45° field of view: 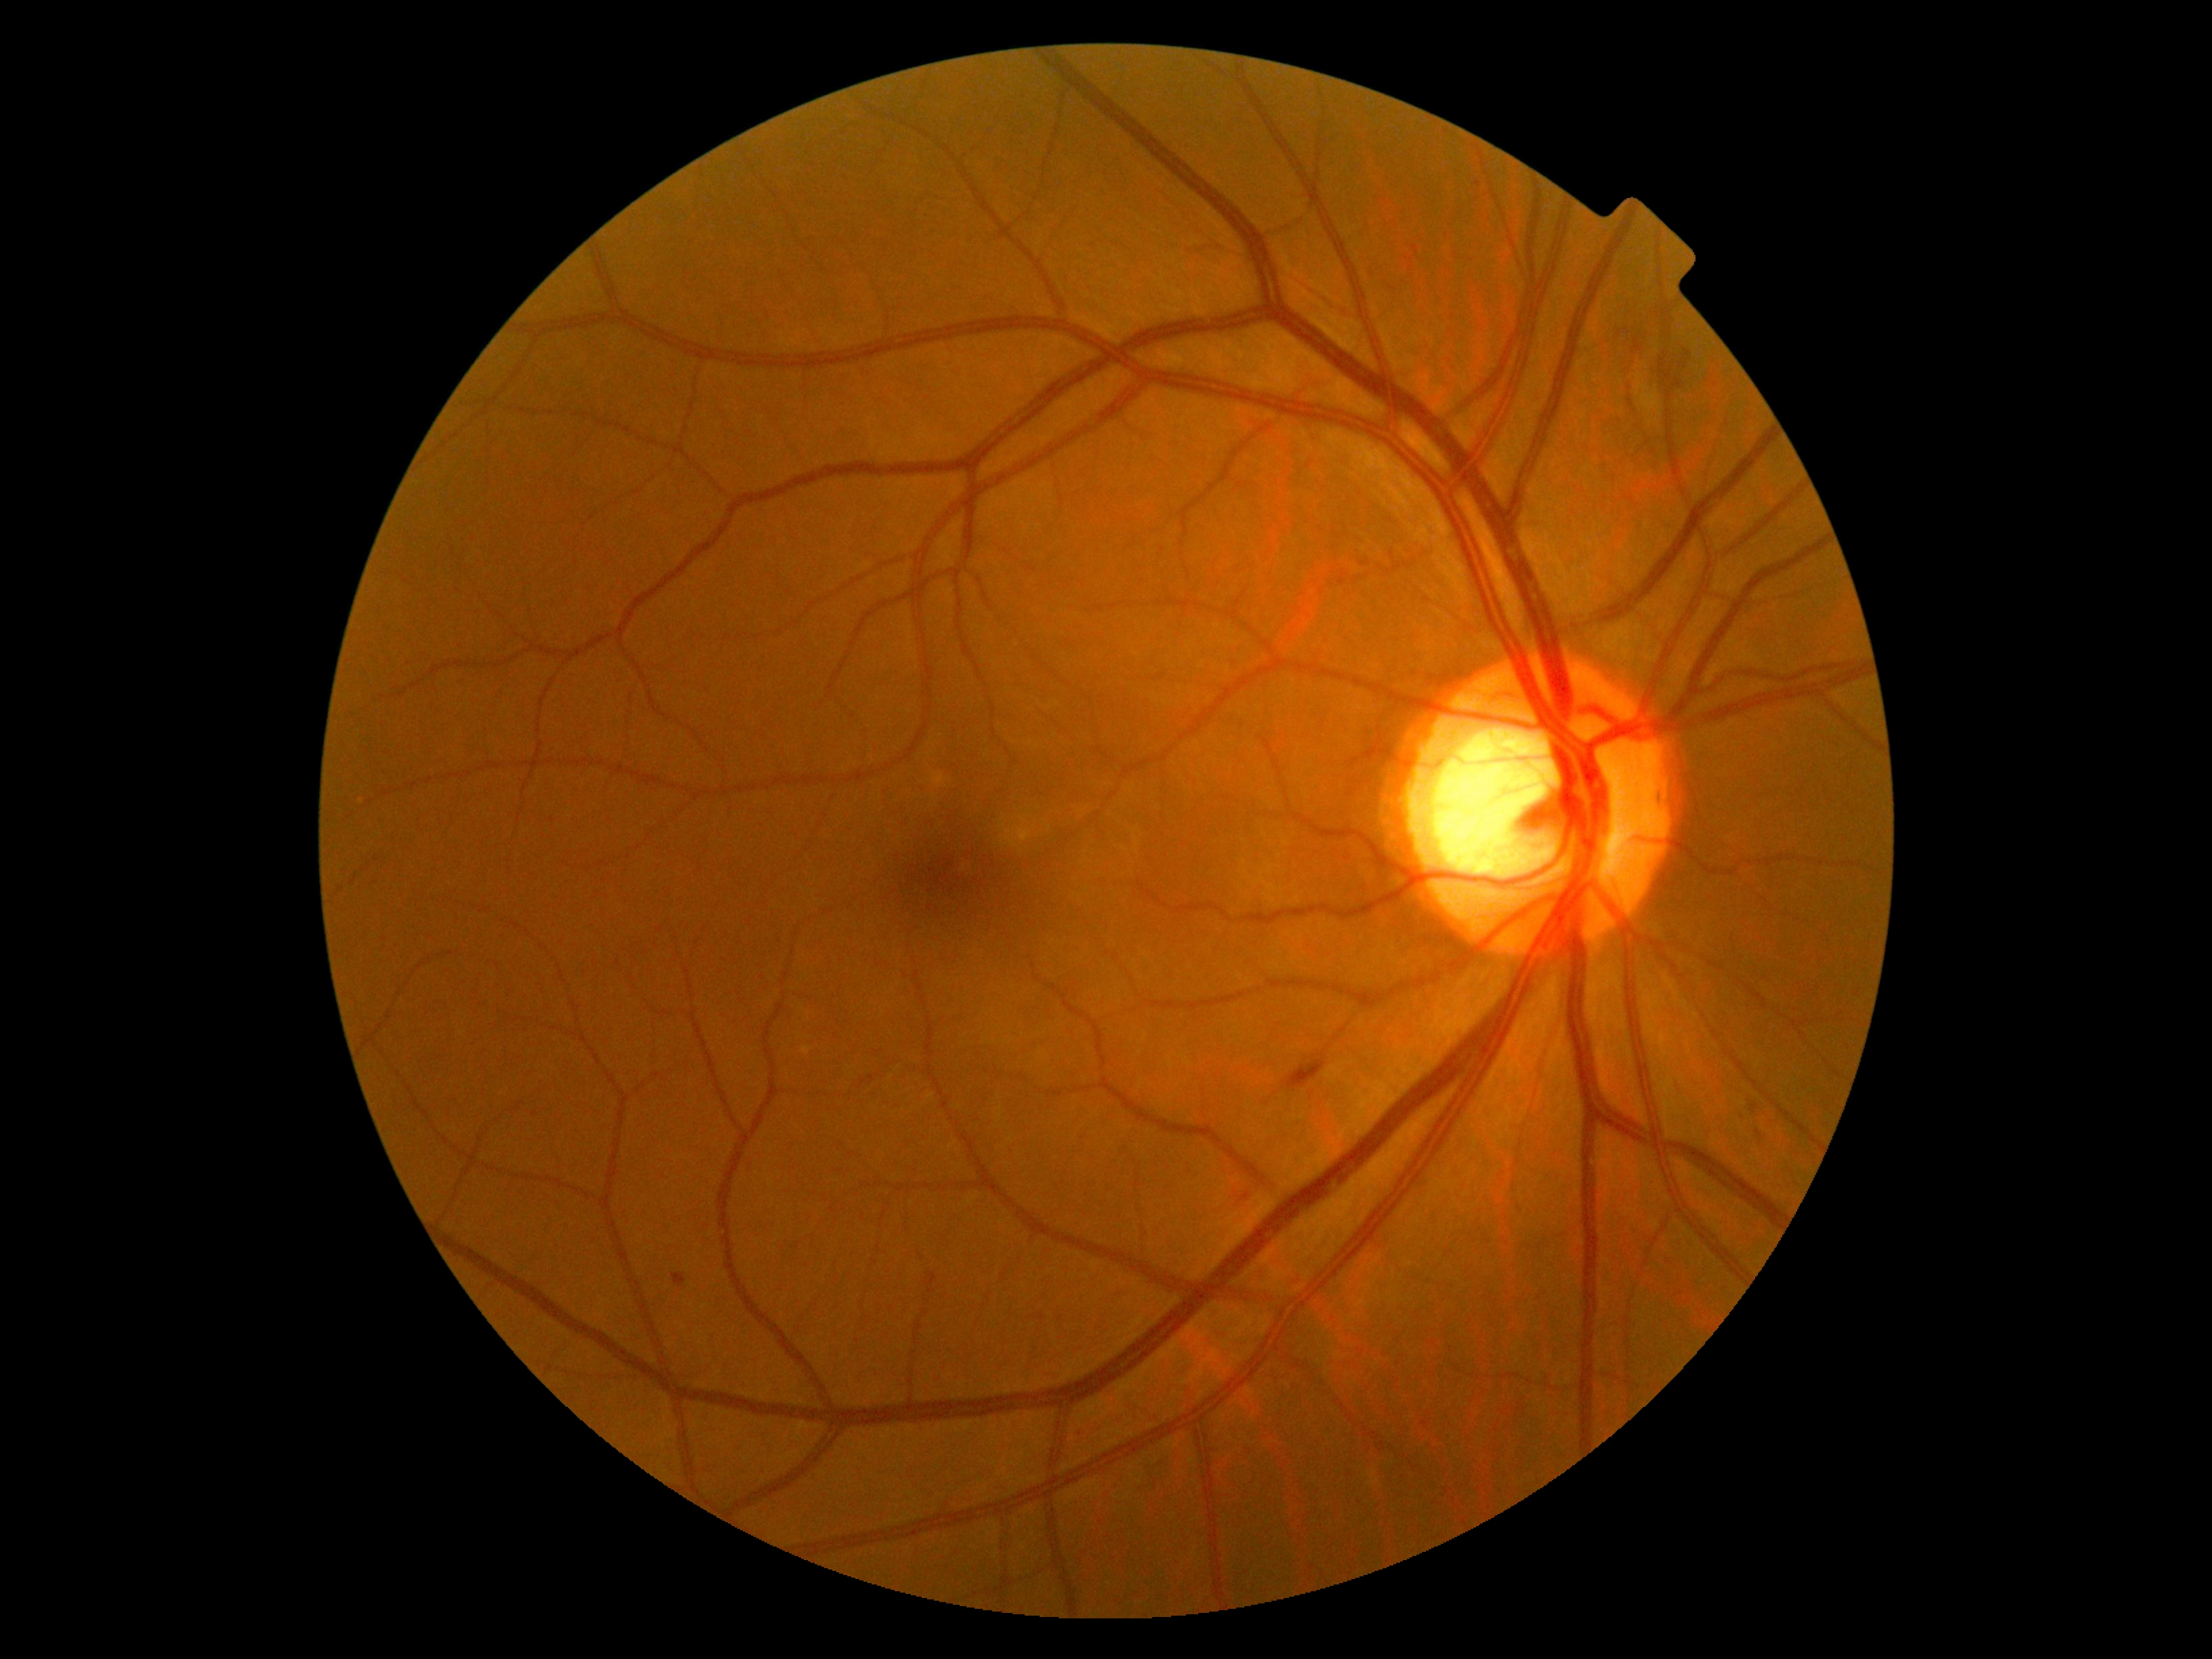
DR severity: 2.
DR class: non-proliferative diabetic retinopathy.